Camera: NIDEK AFC-230, modified Davis classification: 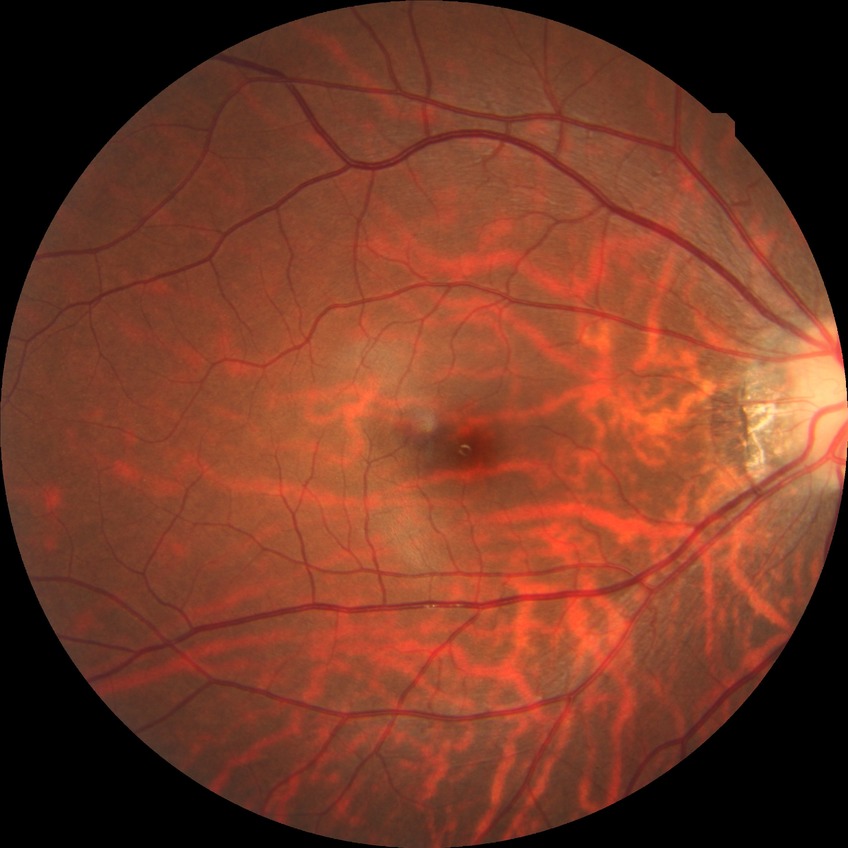 DR stage is NDR.